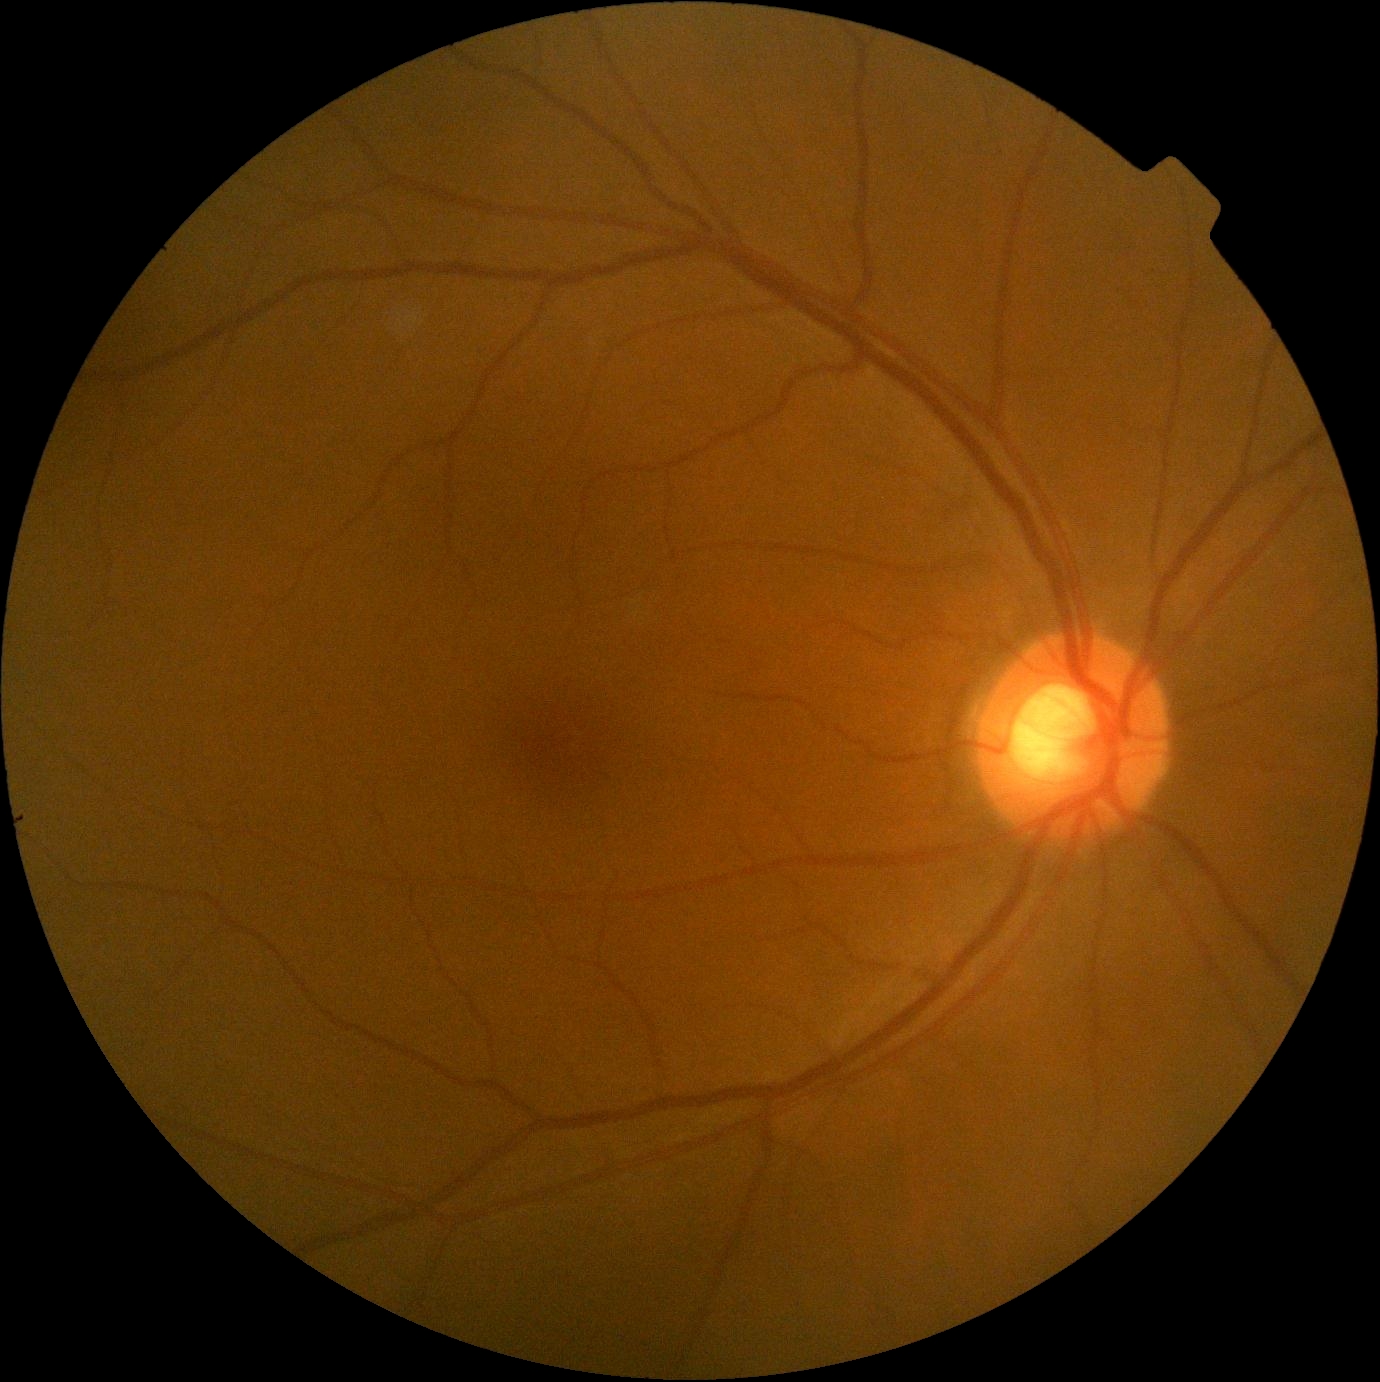 {
  "dr_grade": "no apparent retinopathy (grade 0)",
  "dr_impression": "no signs of DR"
}